Retinal fundus photograph
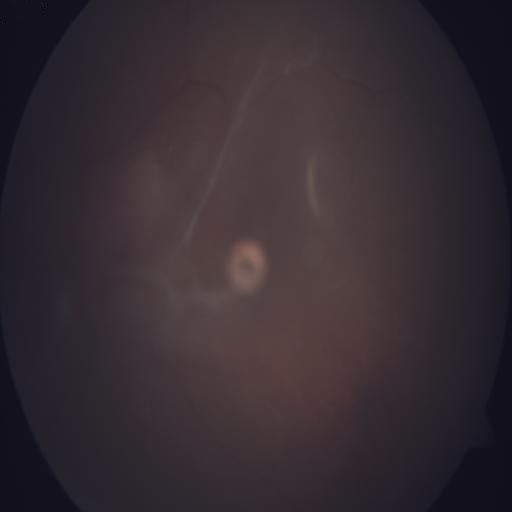 Diagnoses: retinal traction (RT).